DR severity per modified Davis staging:
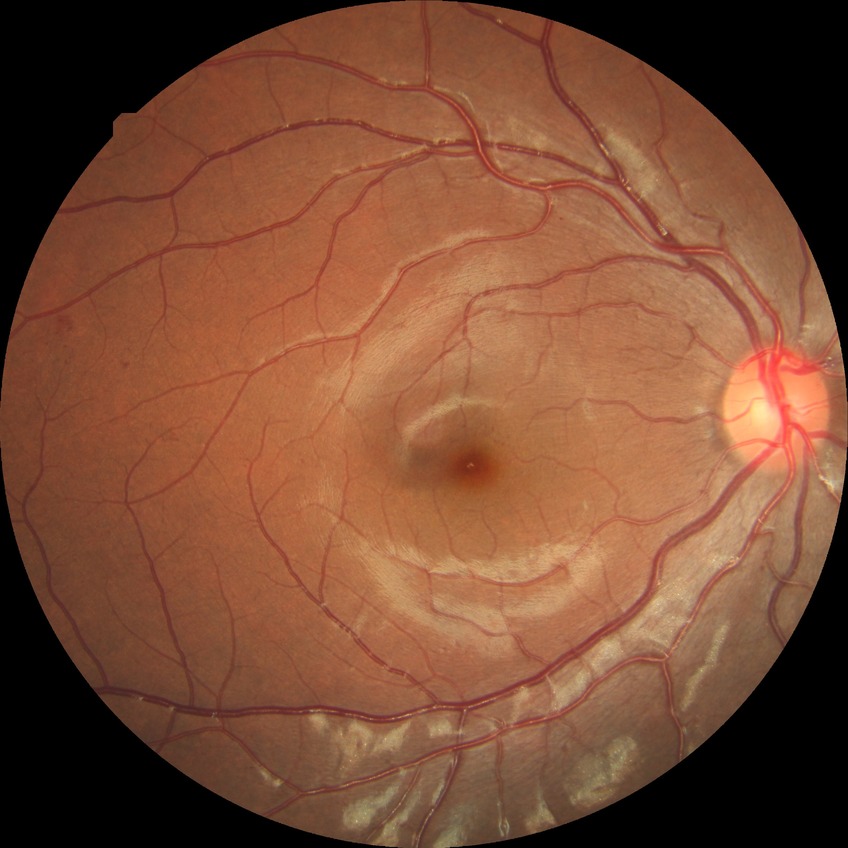 The retinopathy is classified as non-proliferative diabetic retinopathy. Diabetic retinopathy severity is simple diabetic retinopathy.